2352x1568 · CFP · 45° FOV:
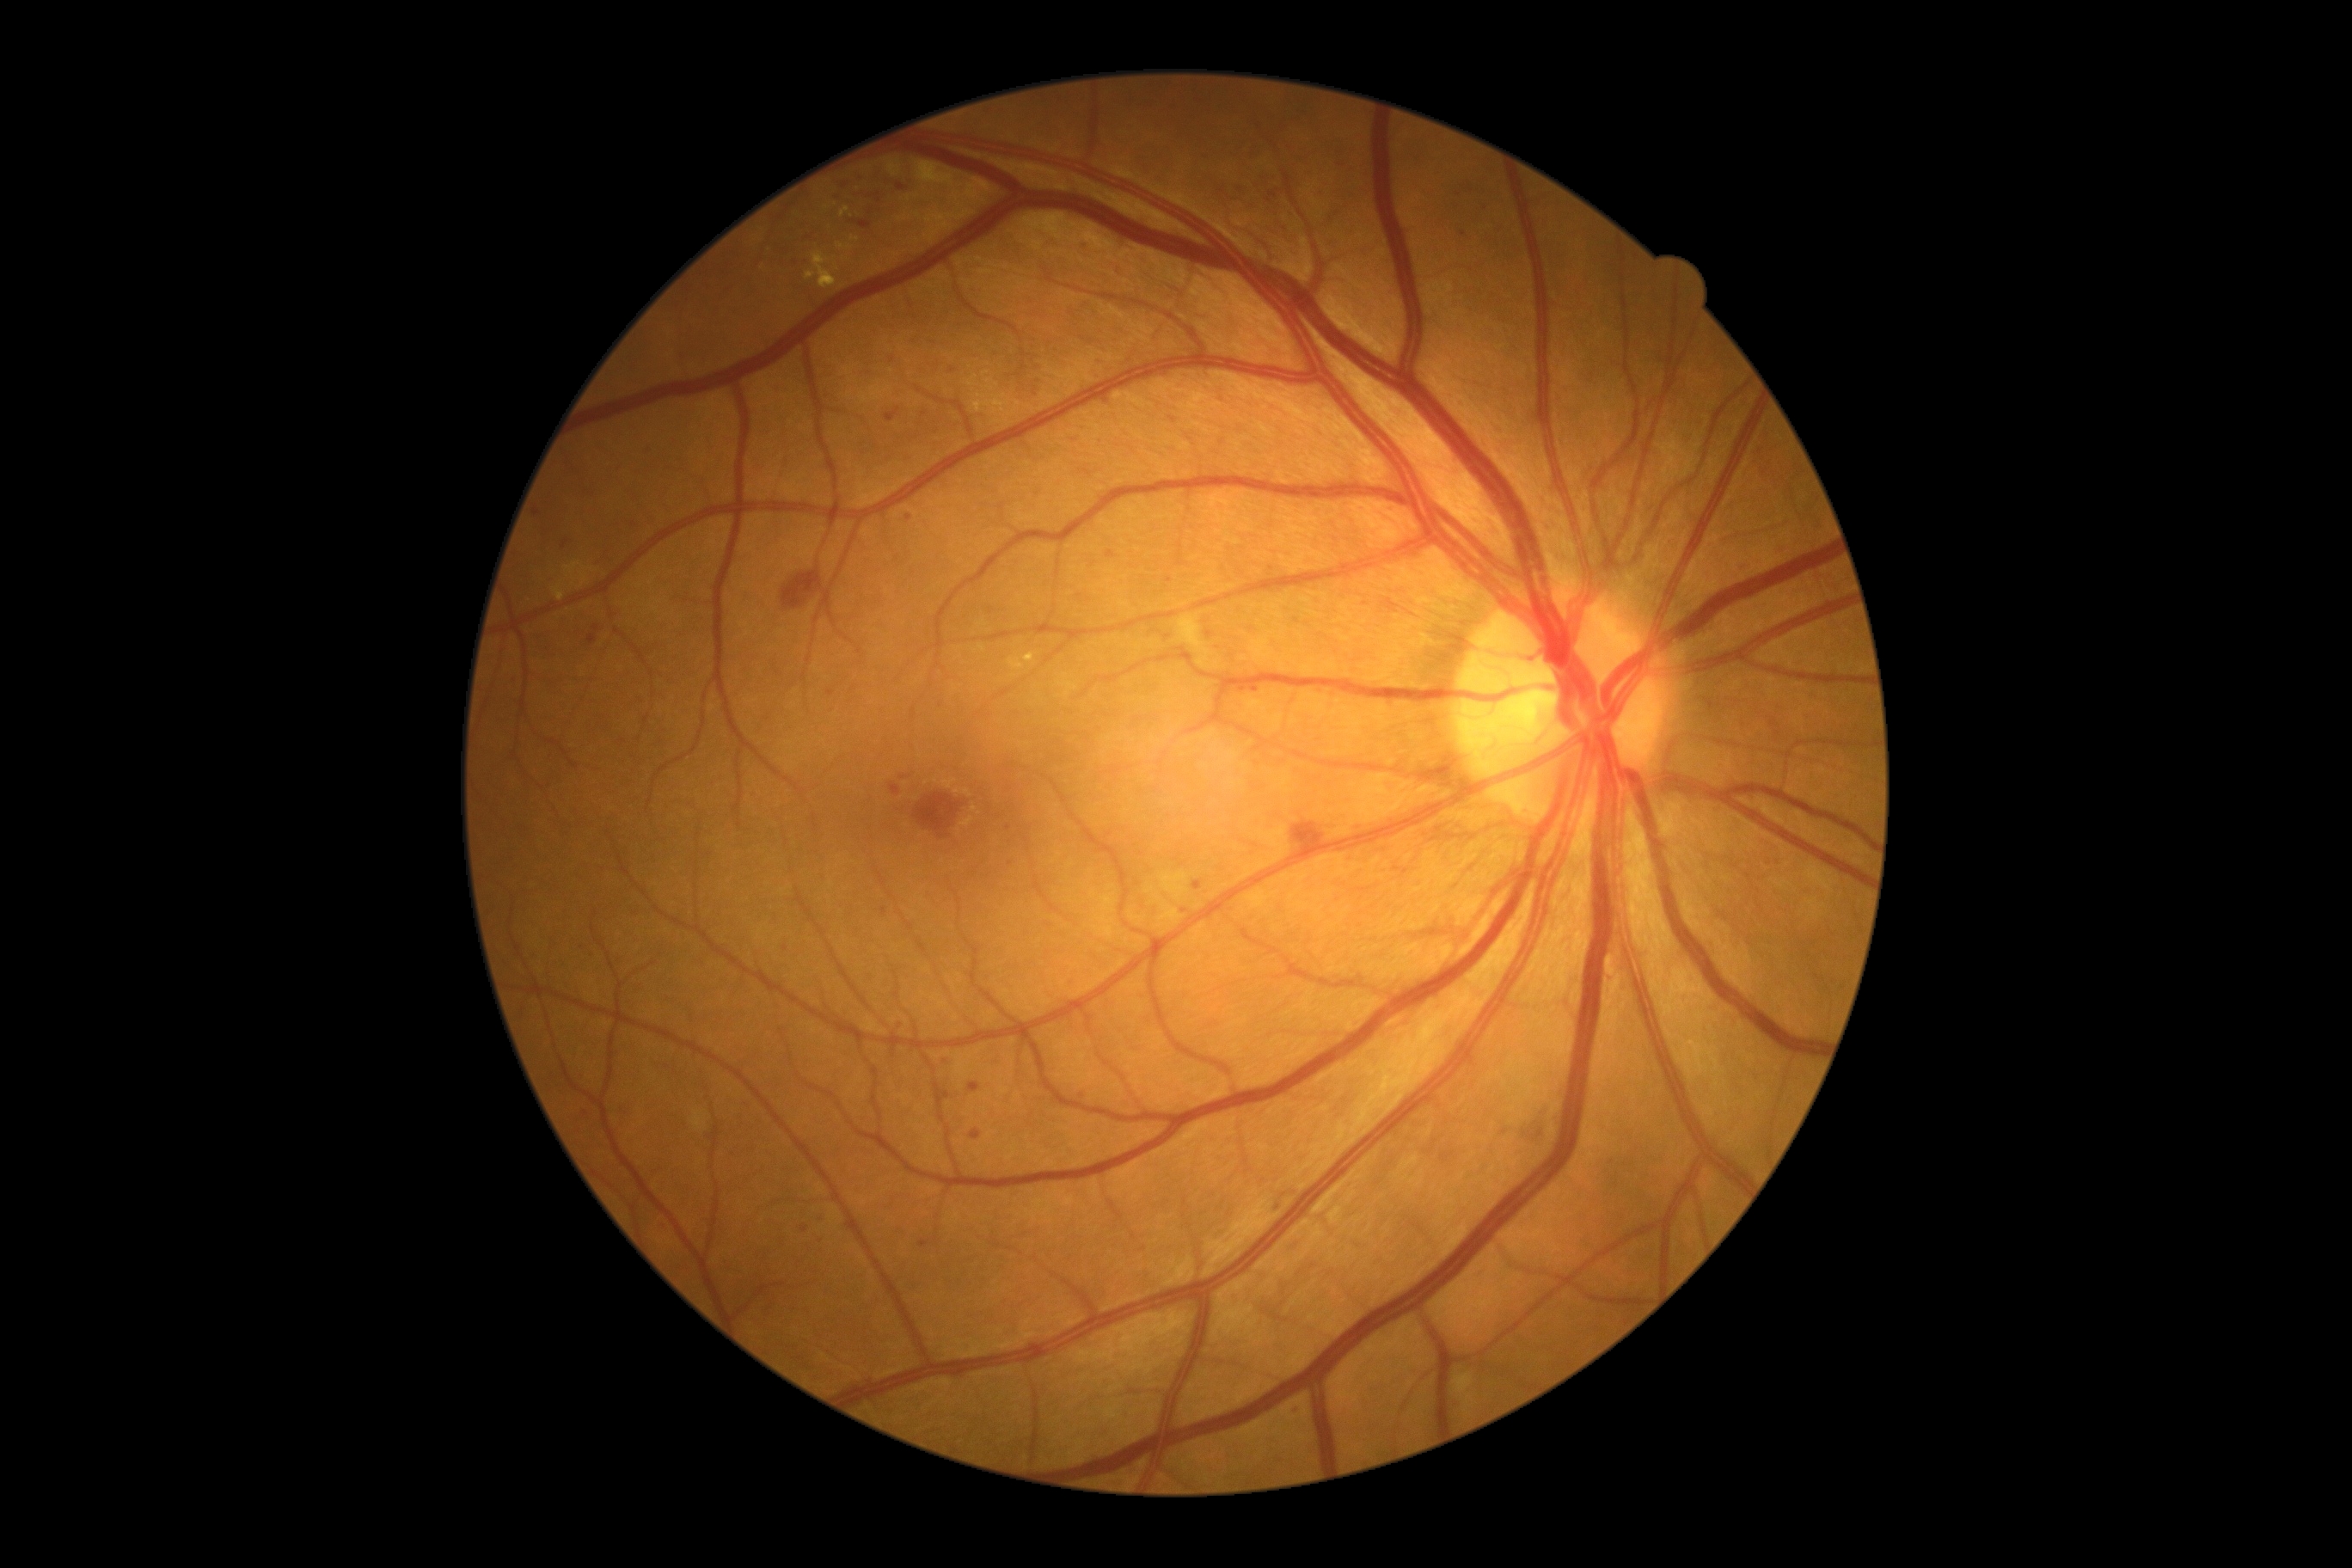

{"partial":true,"dr_grade":2,"lesions":{"ma":[[804,233,814,240],[1034,364,1043,374],[945,1091,950,1101],[890,783,902,797],[1106,551,1117,558],[859,221,873,230],[969,1084,981,1093],[659,1225,668,1232]],"ma_small_centers":[[1778,734],[1008,828],[902,778],[821,1219],[884,912],[565,544],[1002,508],[1269,200],[1088,472]]}}